848x848, color fundus photograph, nonmydriatic:
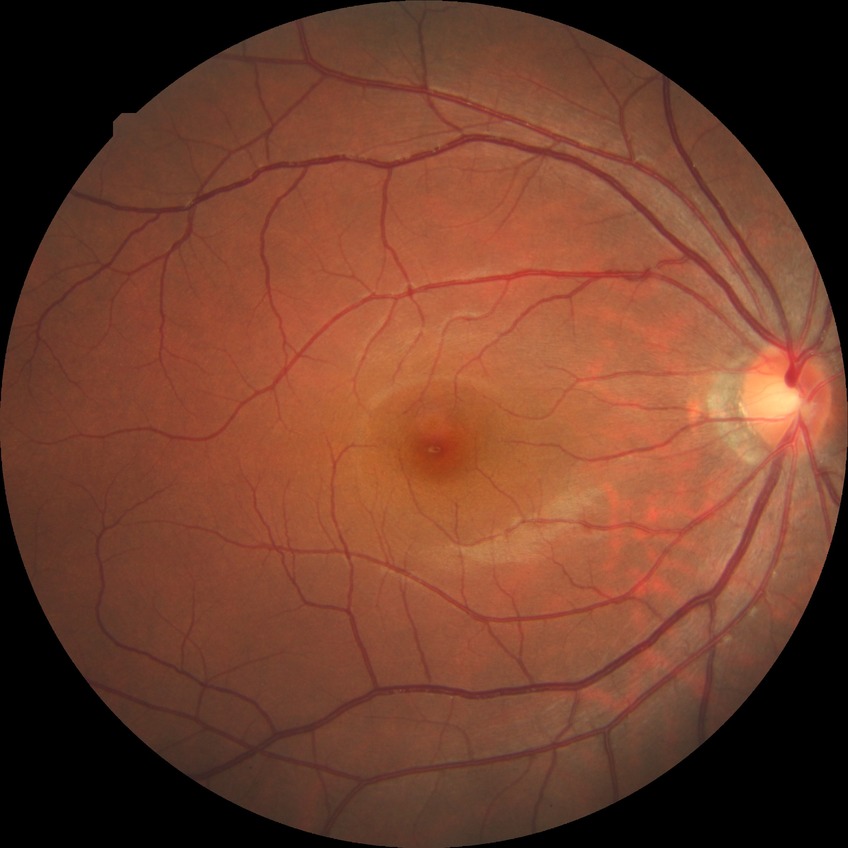
DR stage is NDR.